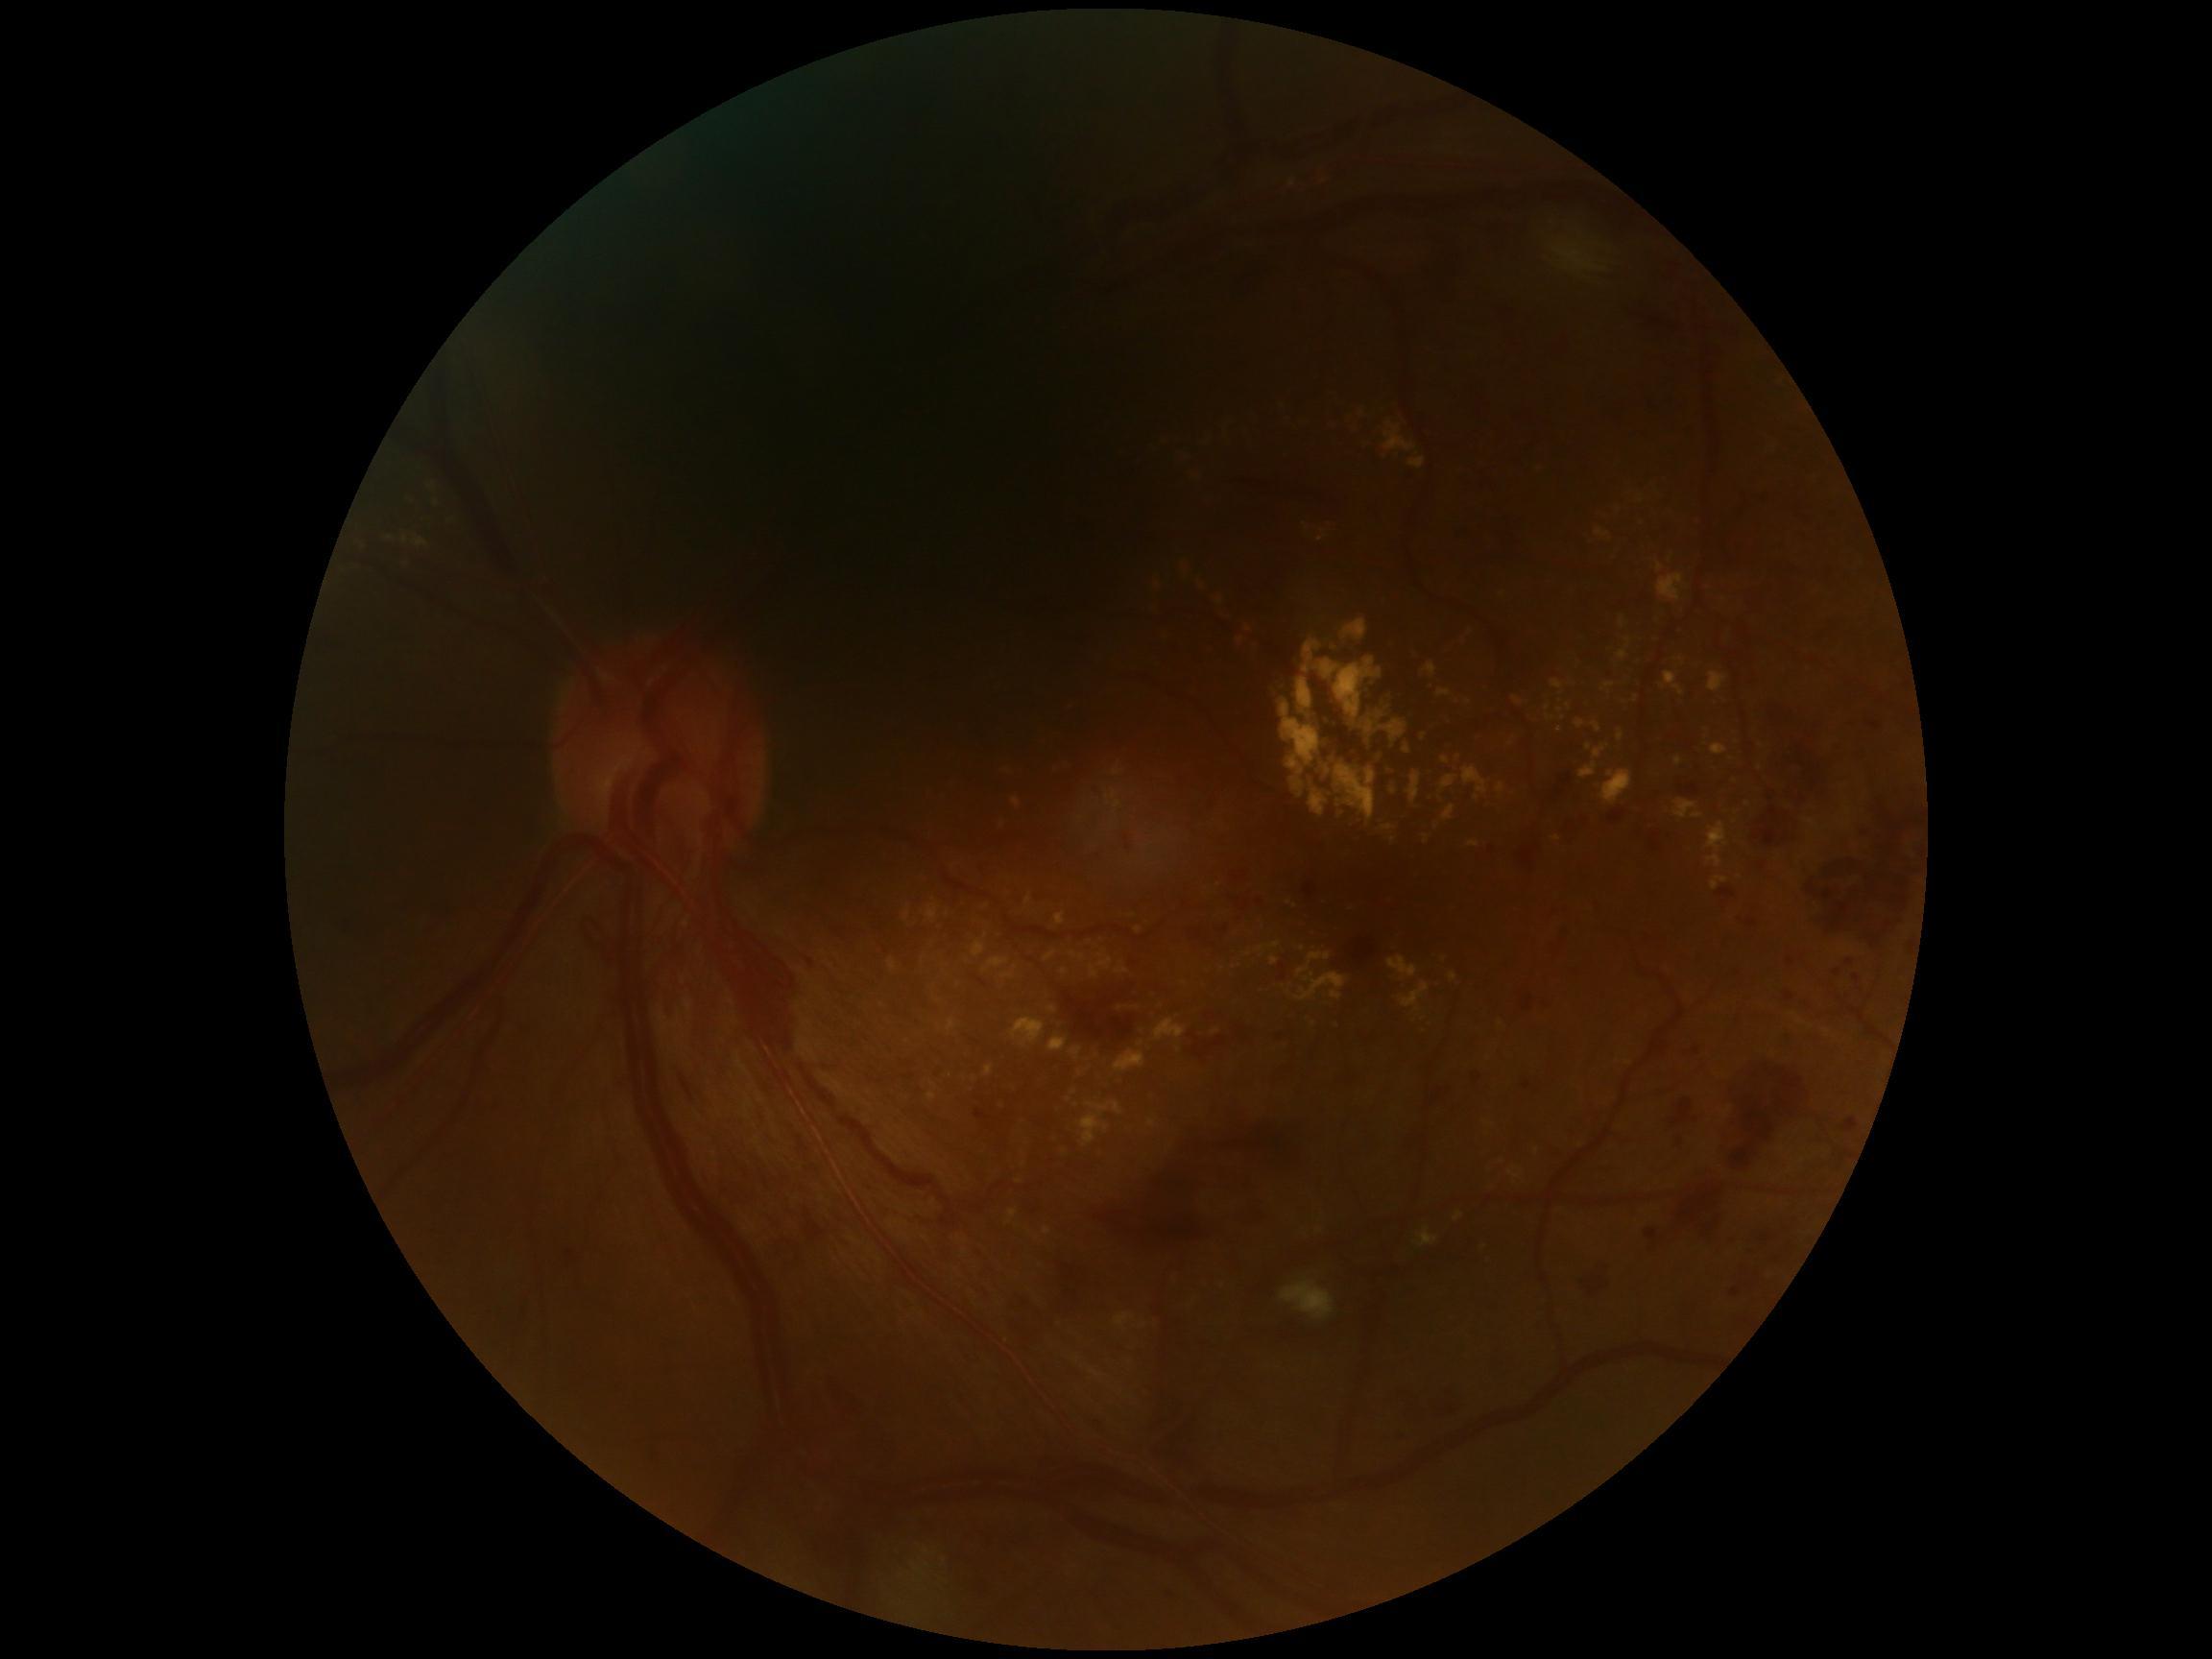
Diabetic retinopathy (DR): proliferative diabetic retinopathy (grade 4).